Color fundus image, 2048 by 1536 pixels.
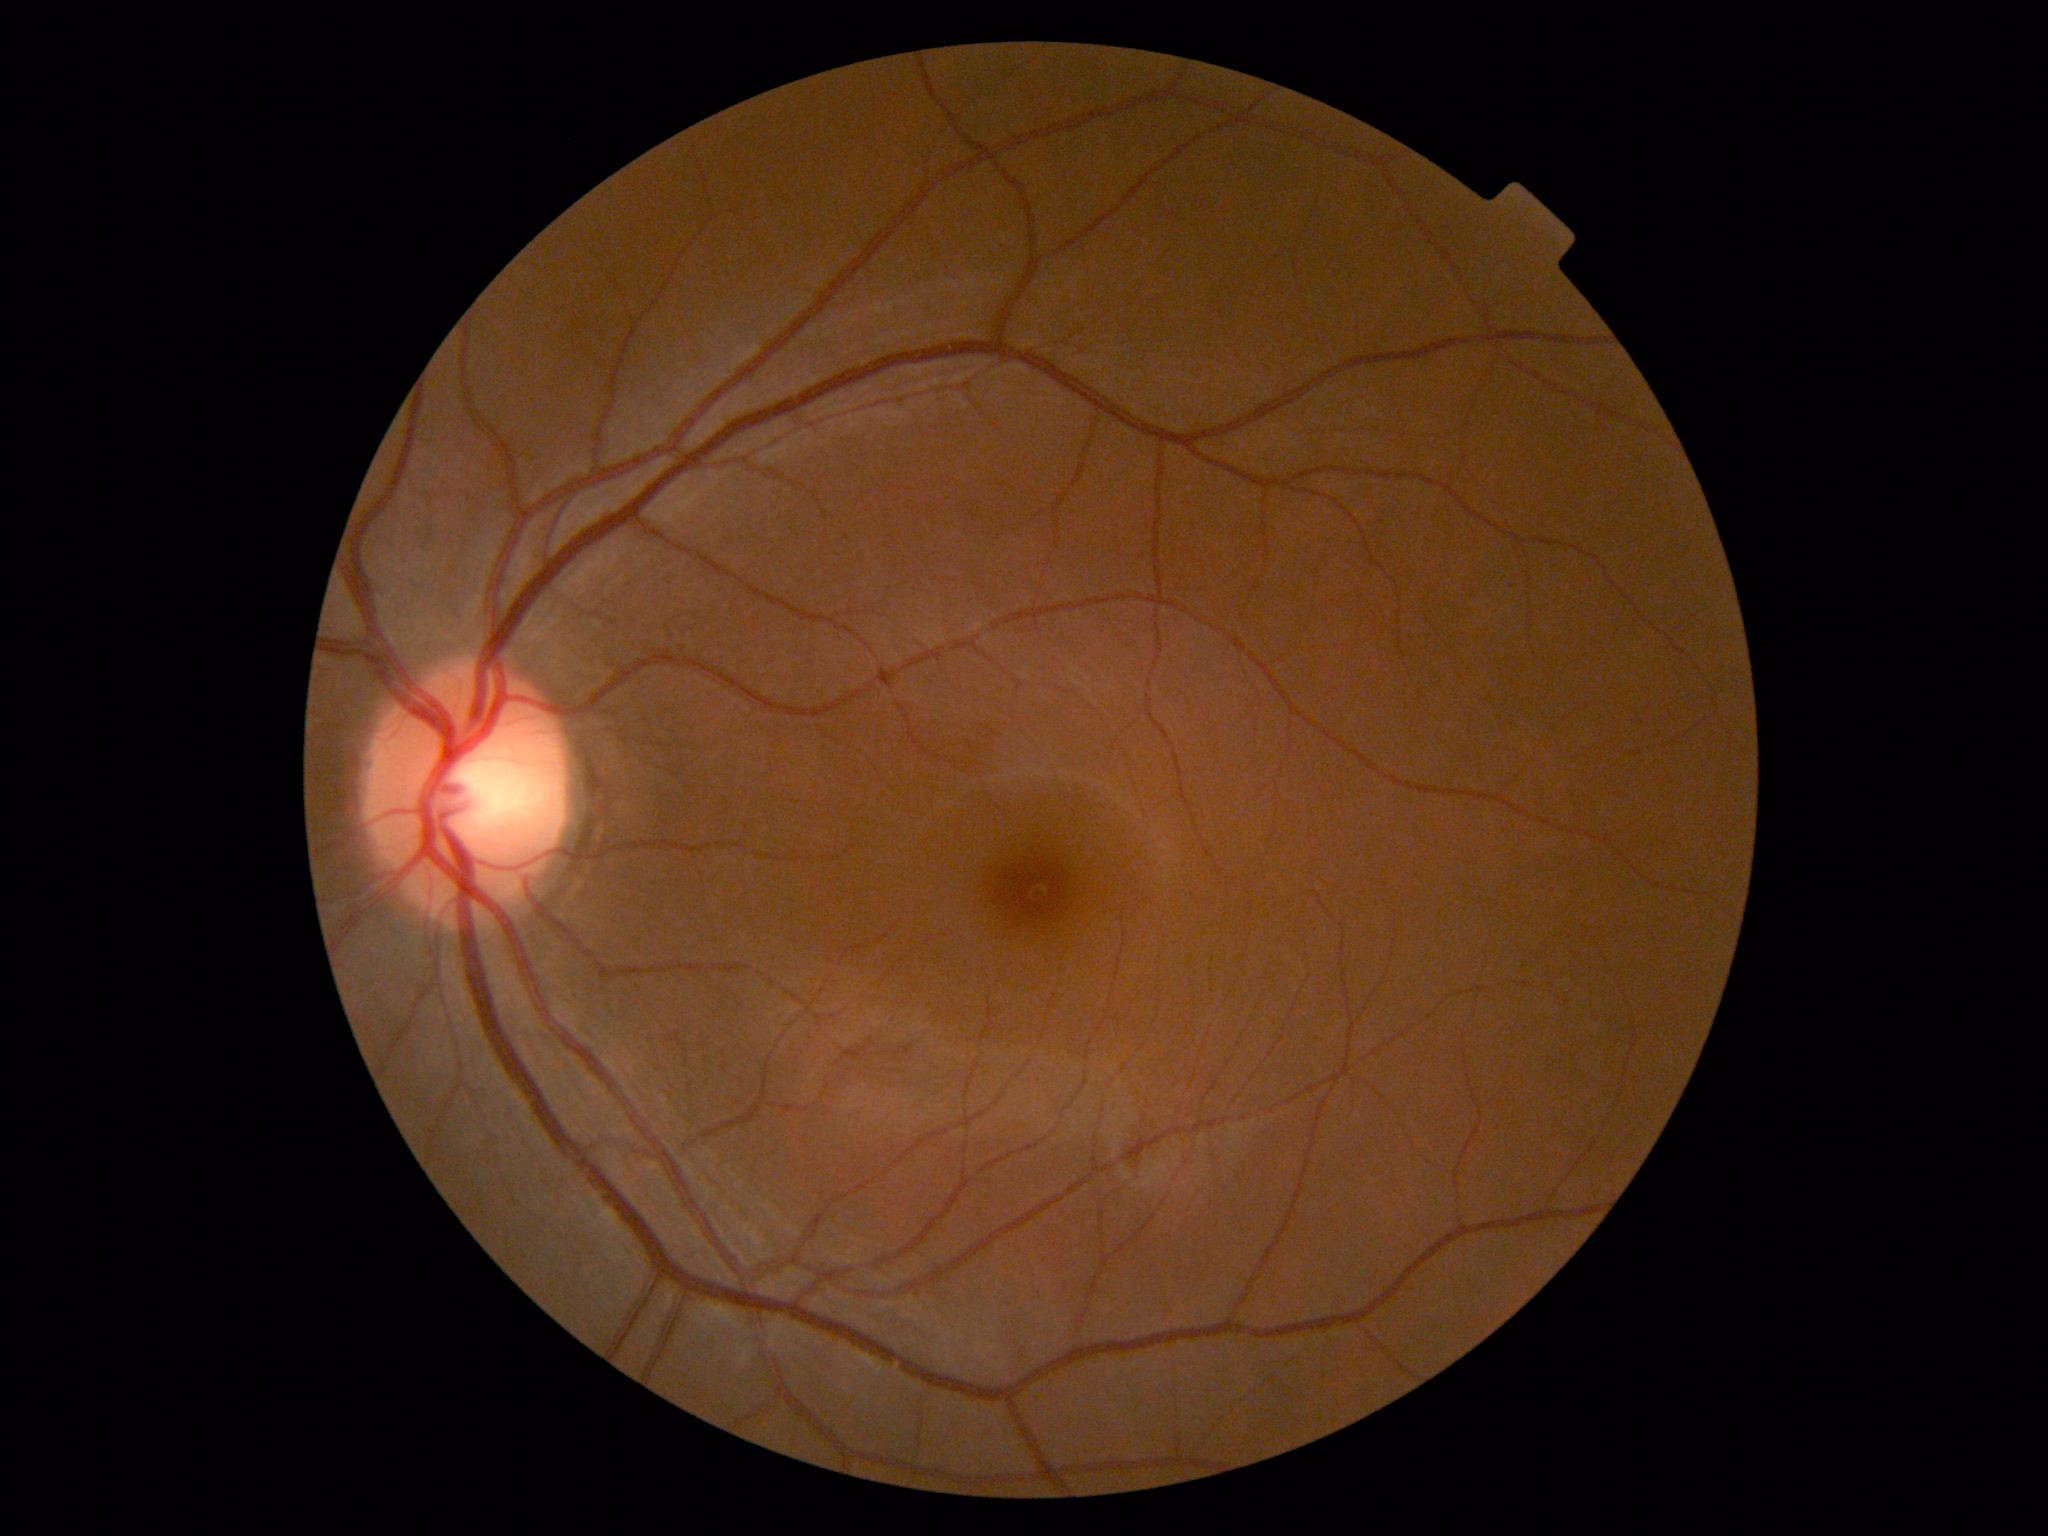

DR is no apparent retinopathy (grade 0).